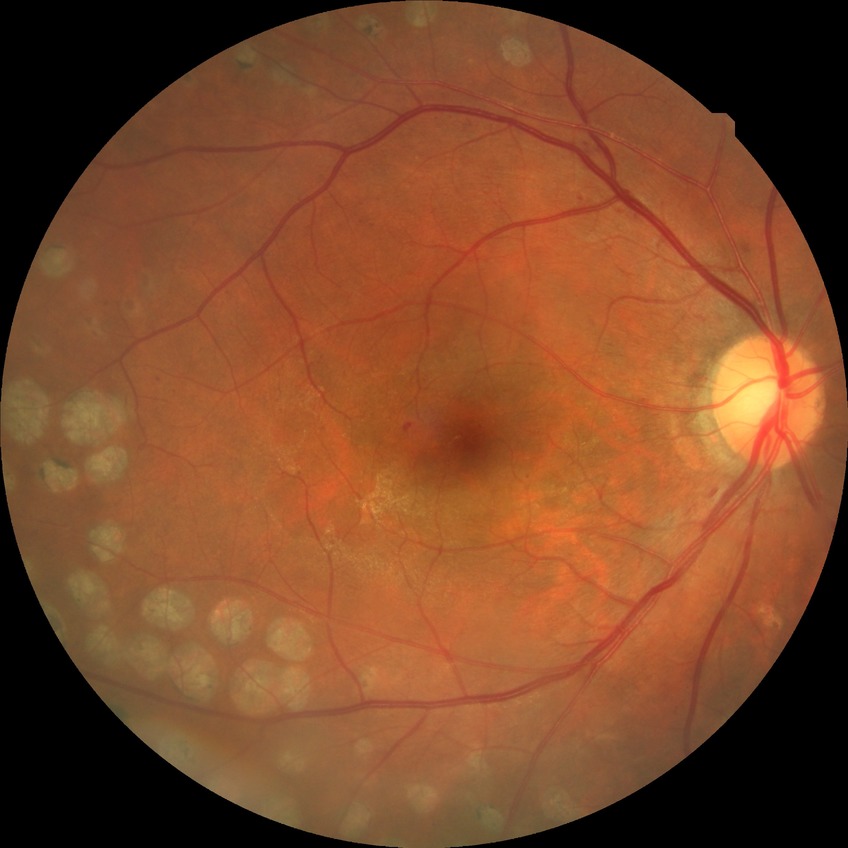
Diabetic retinopathy (DR): proliferative diabetic retinopathy (PDR).